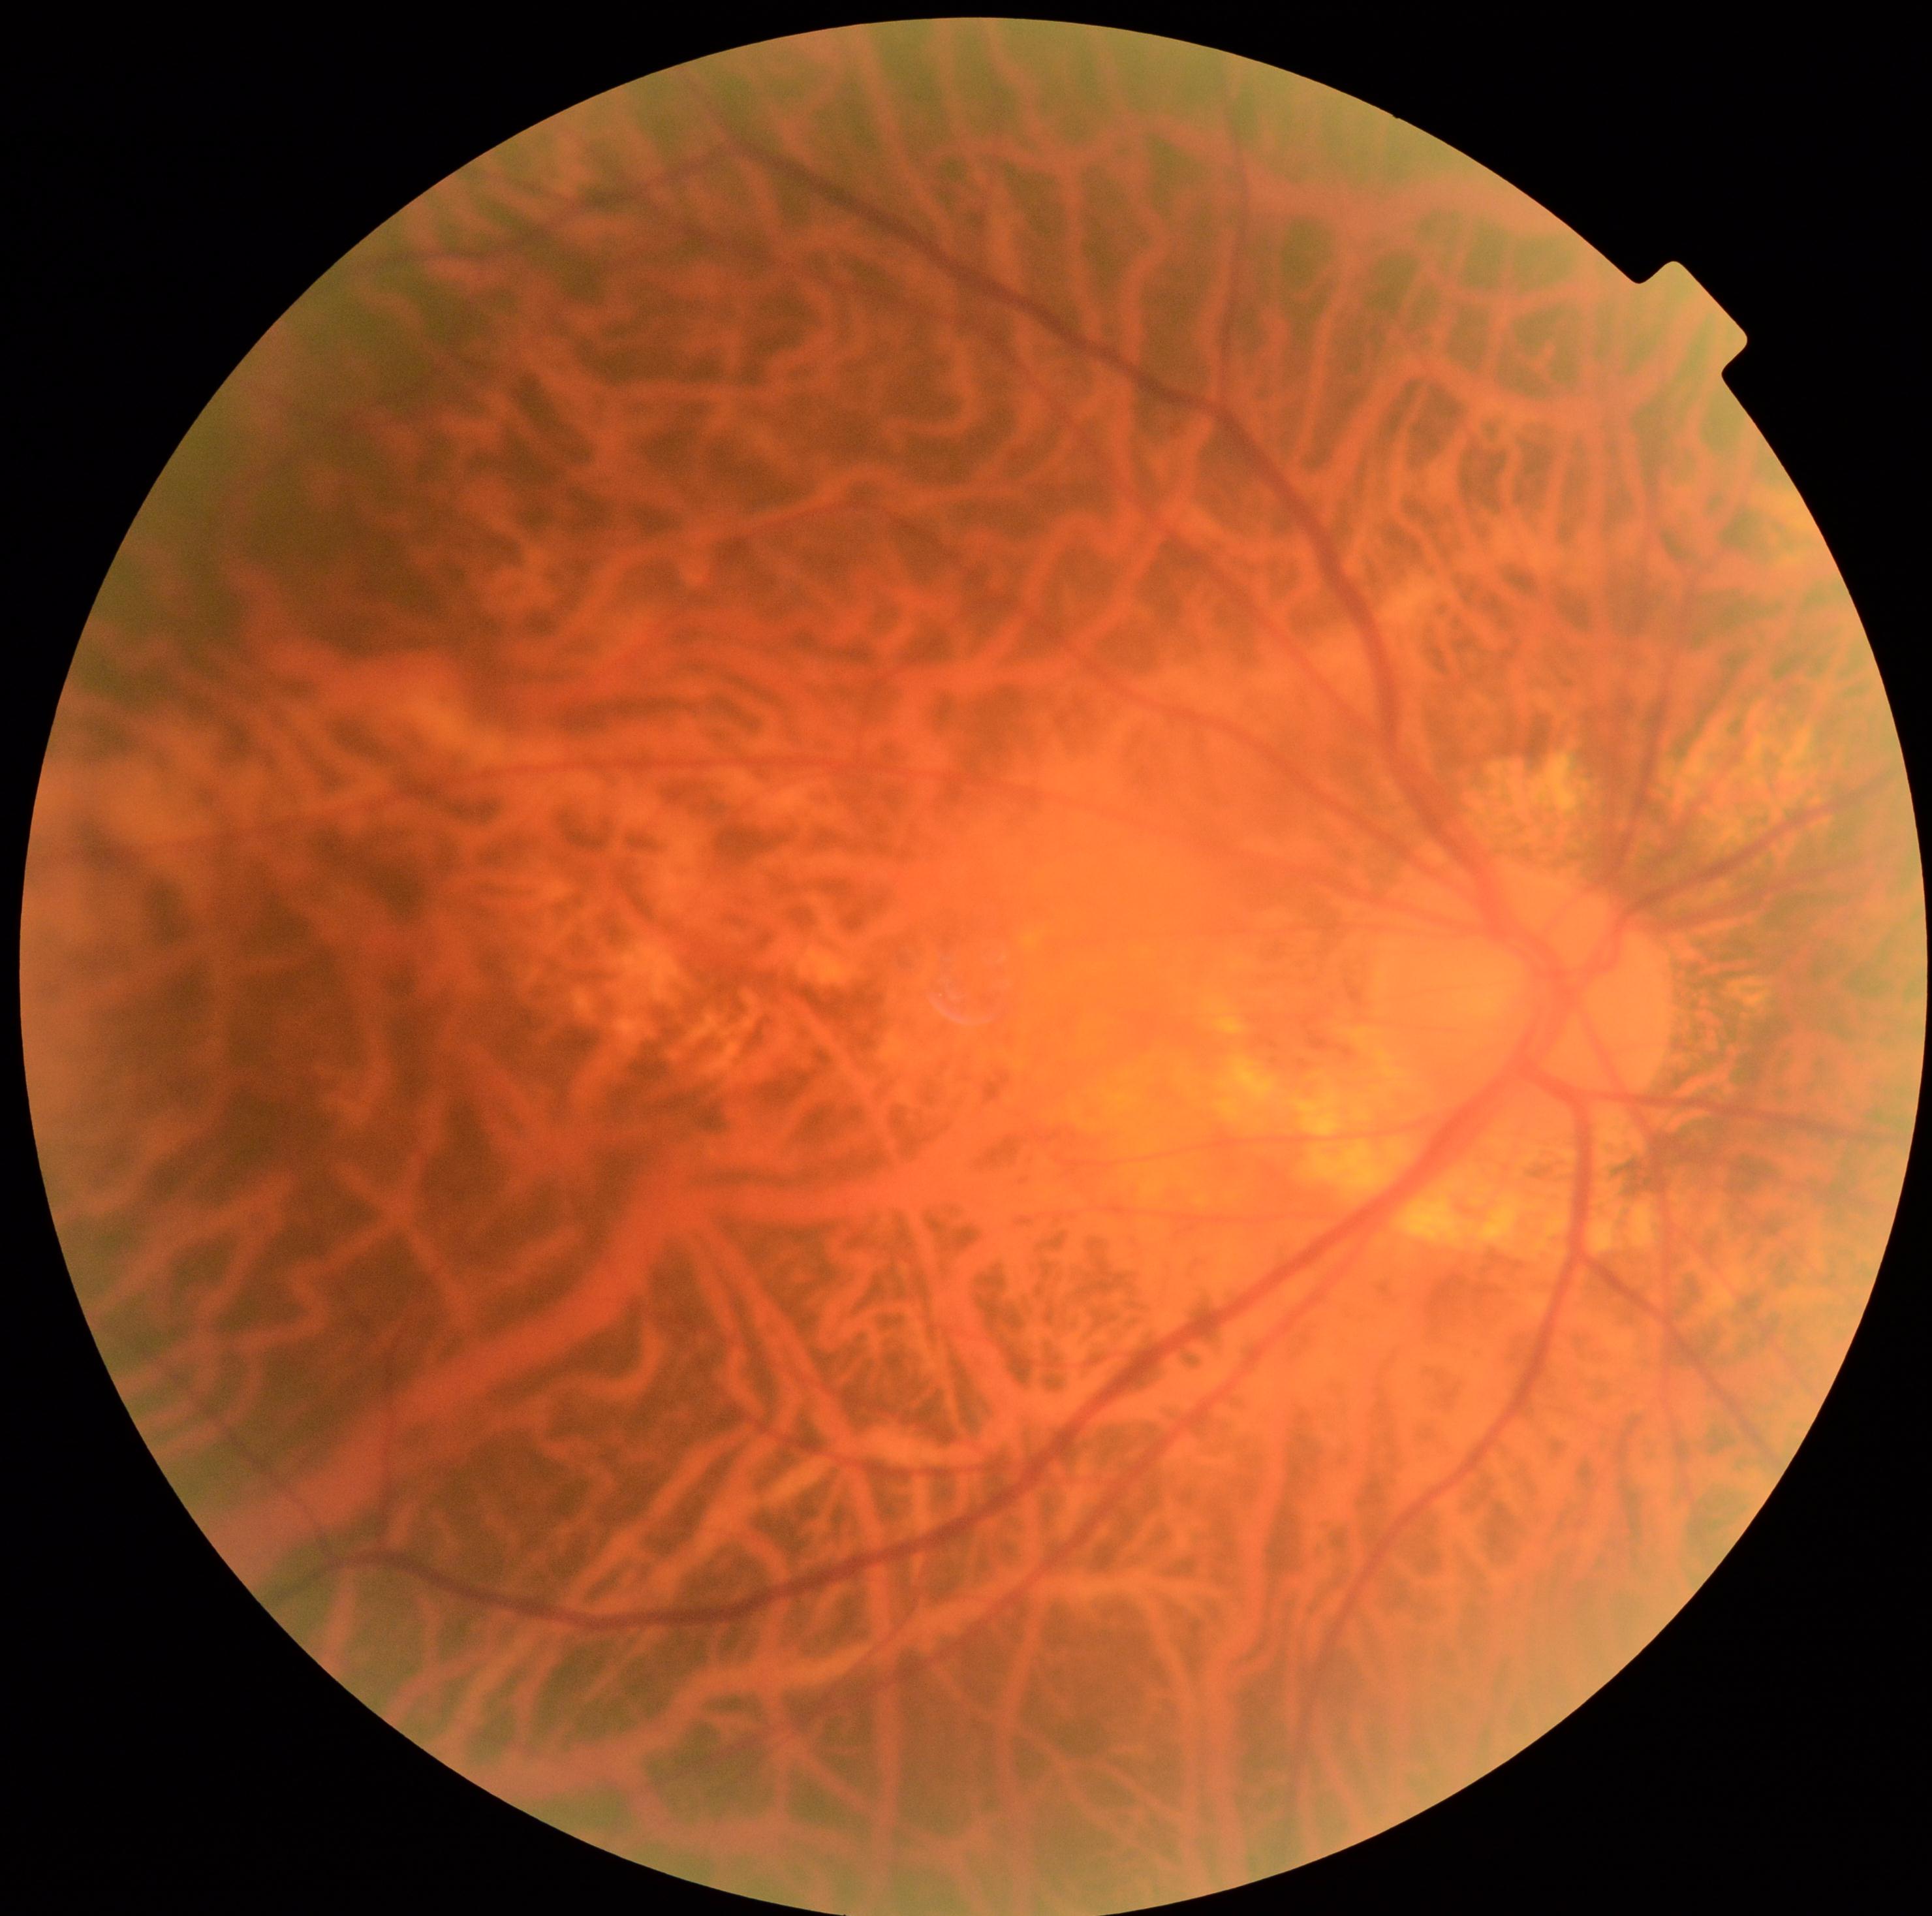 diabetic retinopathy (DR)@grade 0 (no apparent retinopathy).